45° FOV, image size 1725x1721.
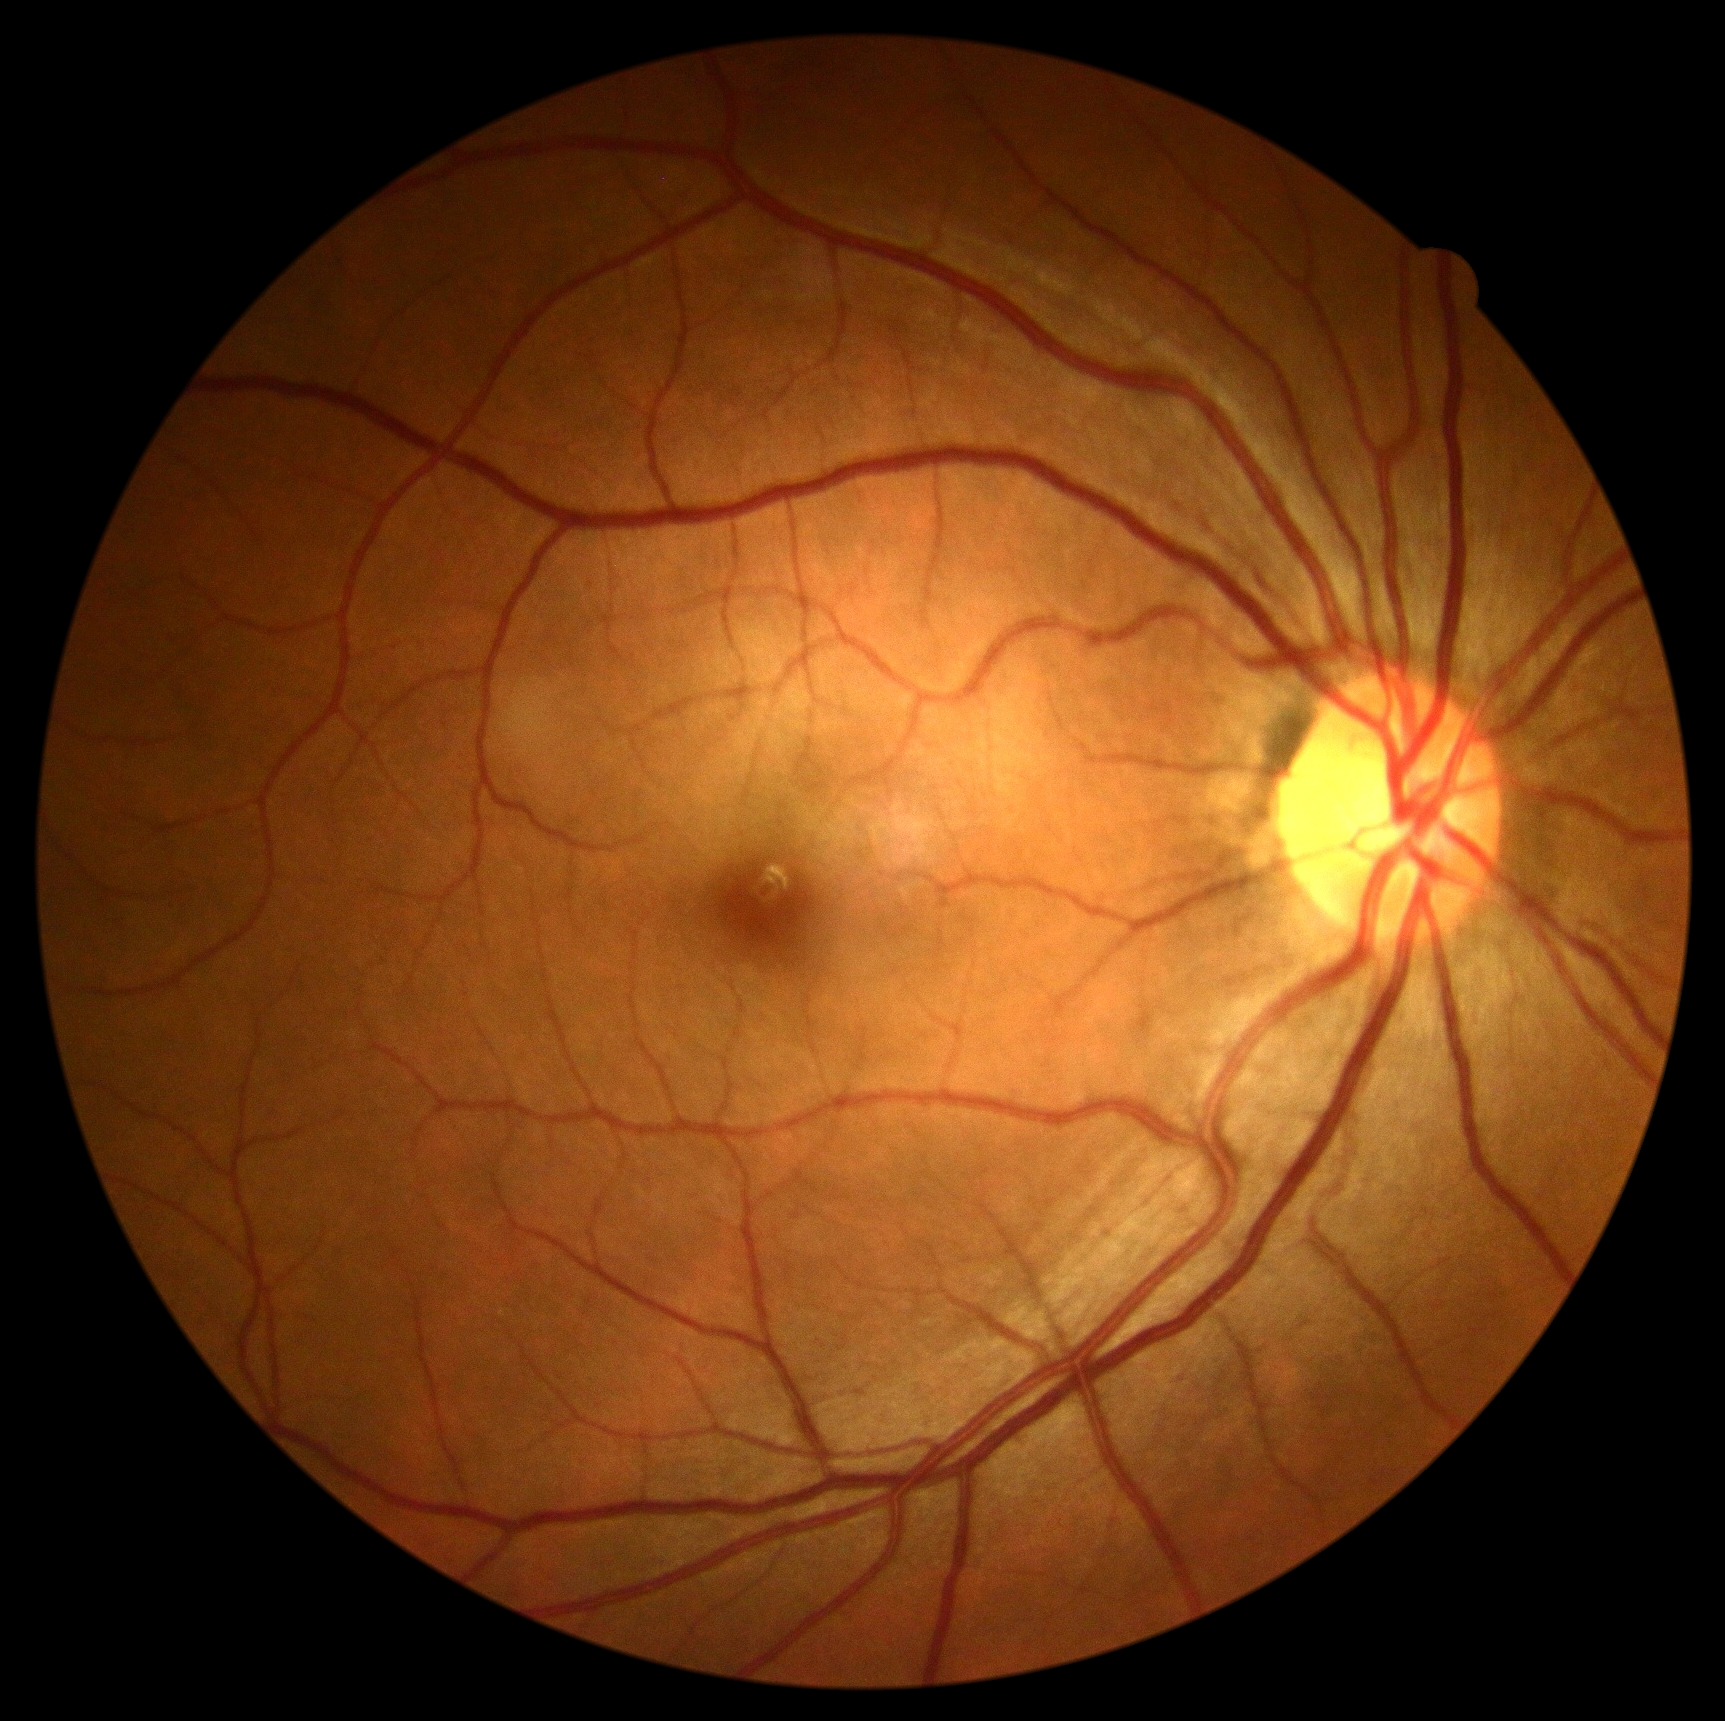
{
  "dr_impression": "no DR findings",
  "dr_grade": "grade 0"
}